RetCam wide-field infant fundus image.
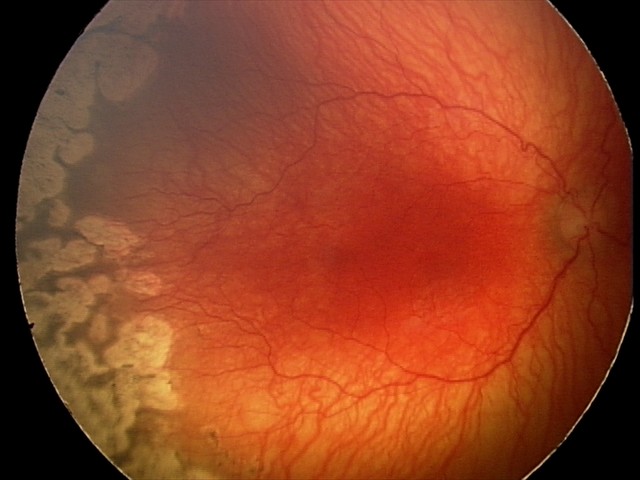
Screening series with aggressive retinopathy of prematurity — rapidly progressive severe ROP with prominent plus disease, often without classic stage progression.